Pediatric retinal photograph (wide-field); 1240 by 1240 pixels
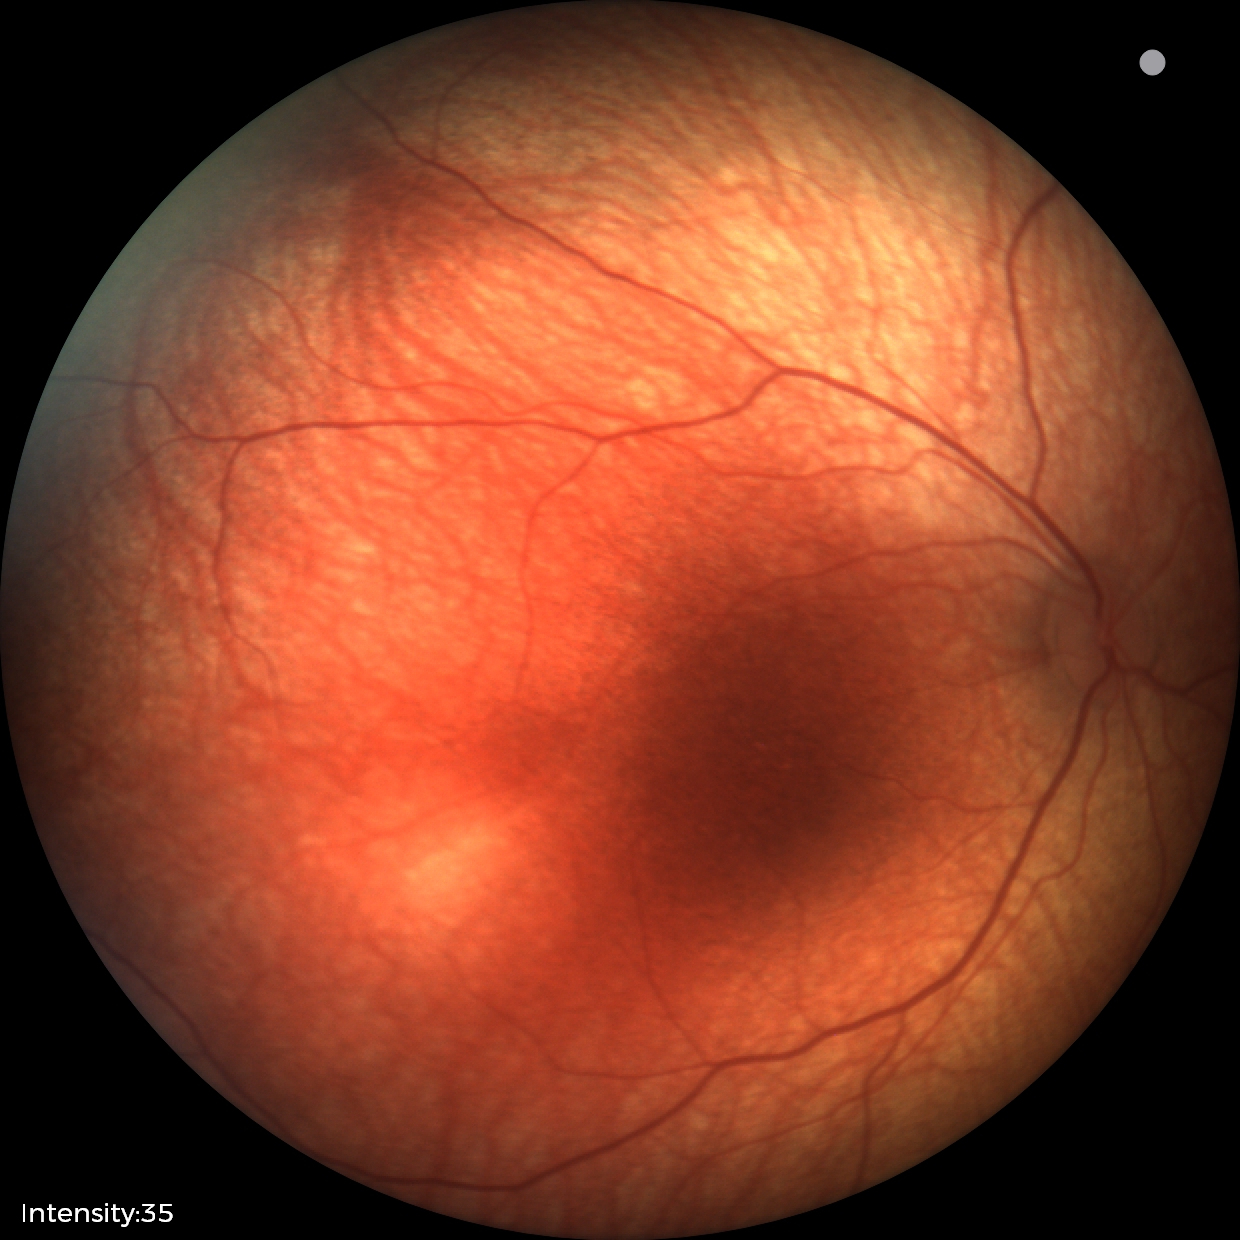

Screening: physiological retinal finding.